Optic disc region crop.
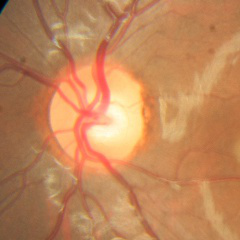

There is evidence of no glaucomatous changes.